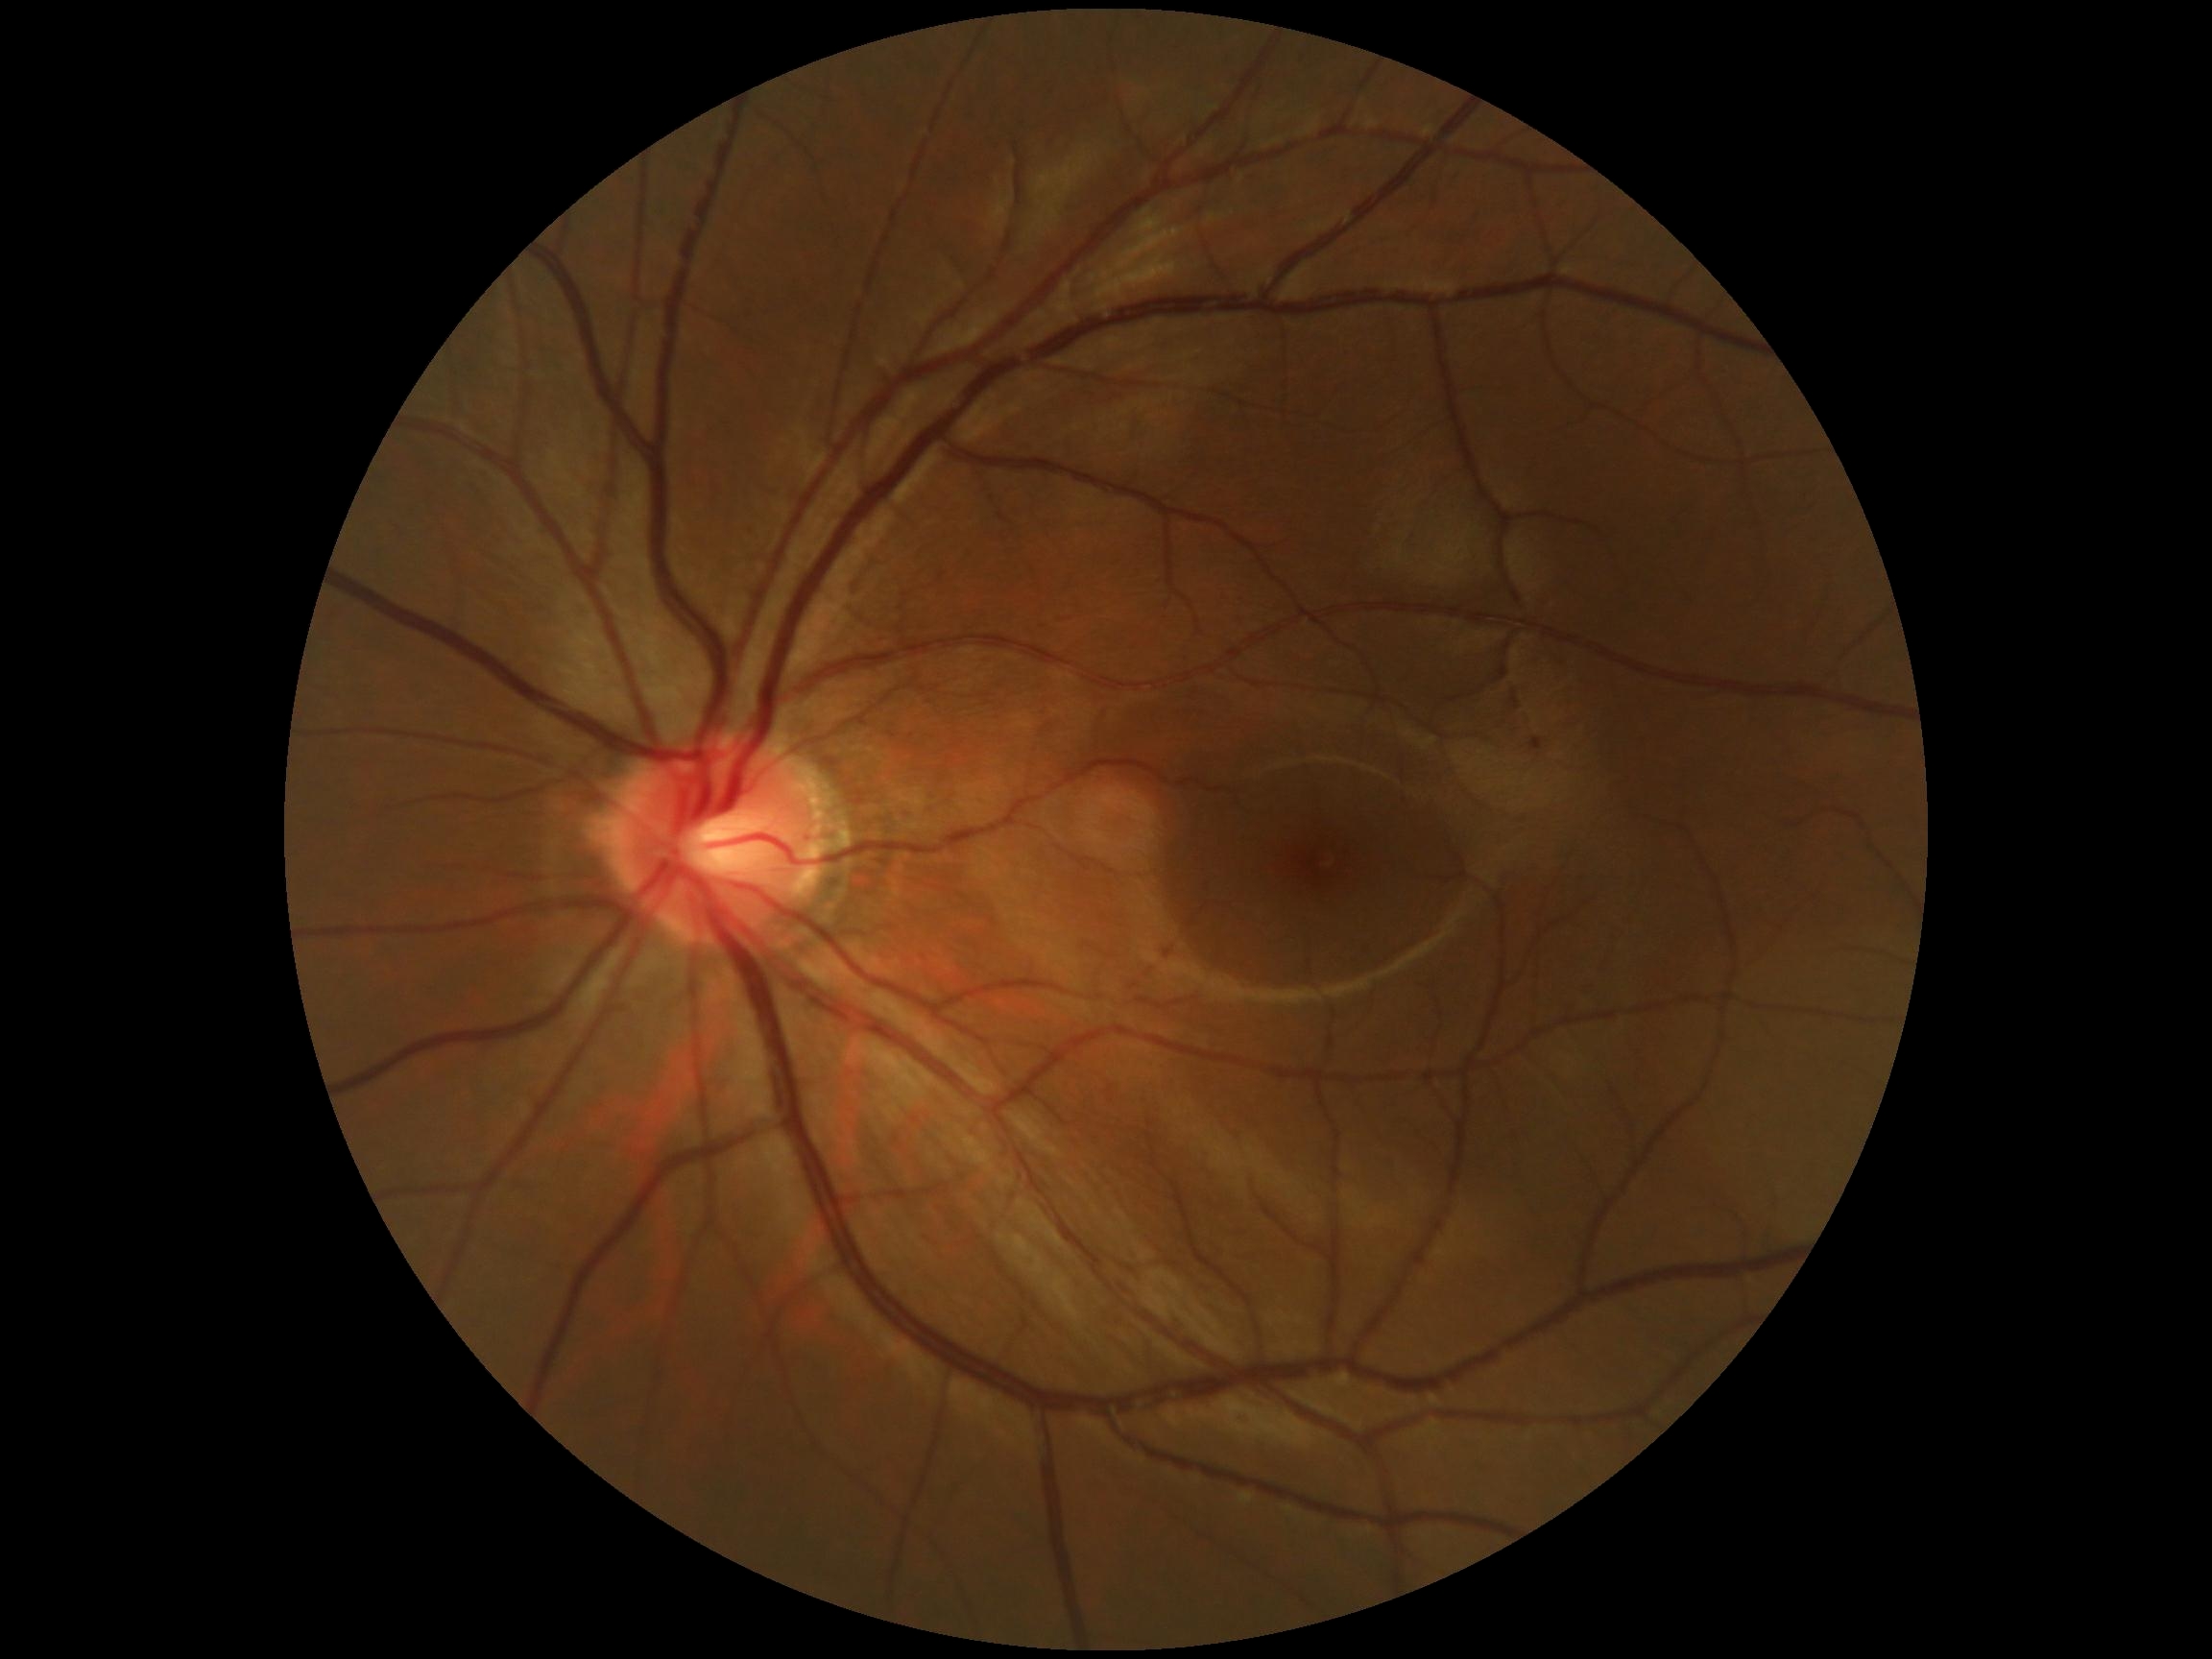

{"dr_grade": "grade 0", "dr_impression": "negative for DR"}